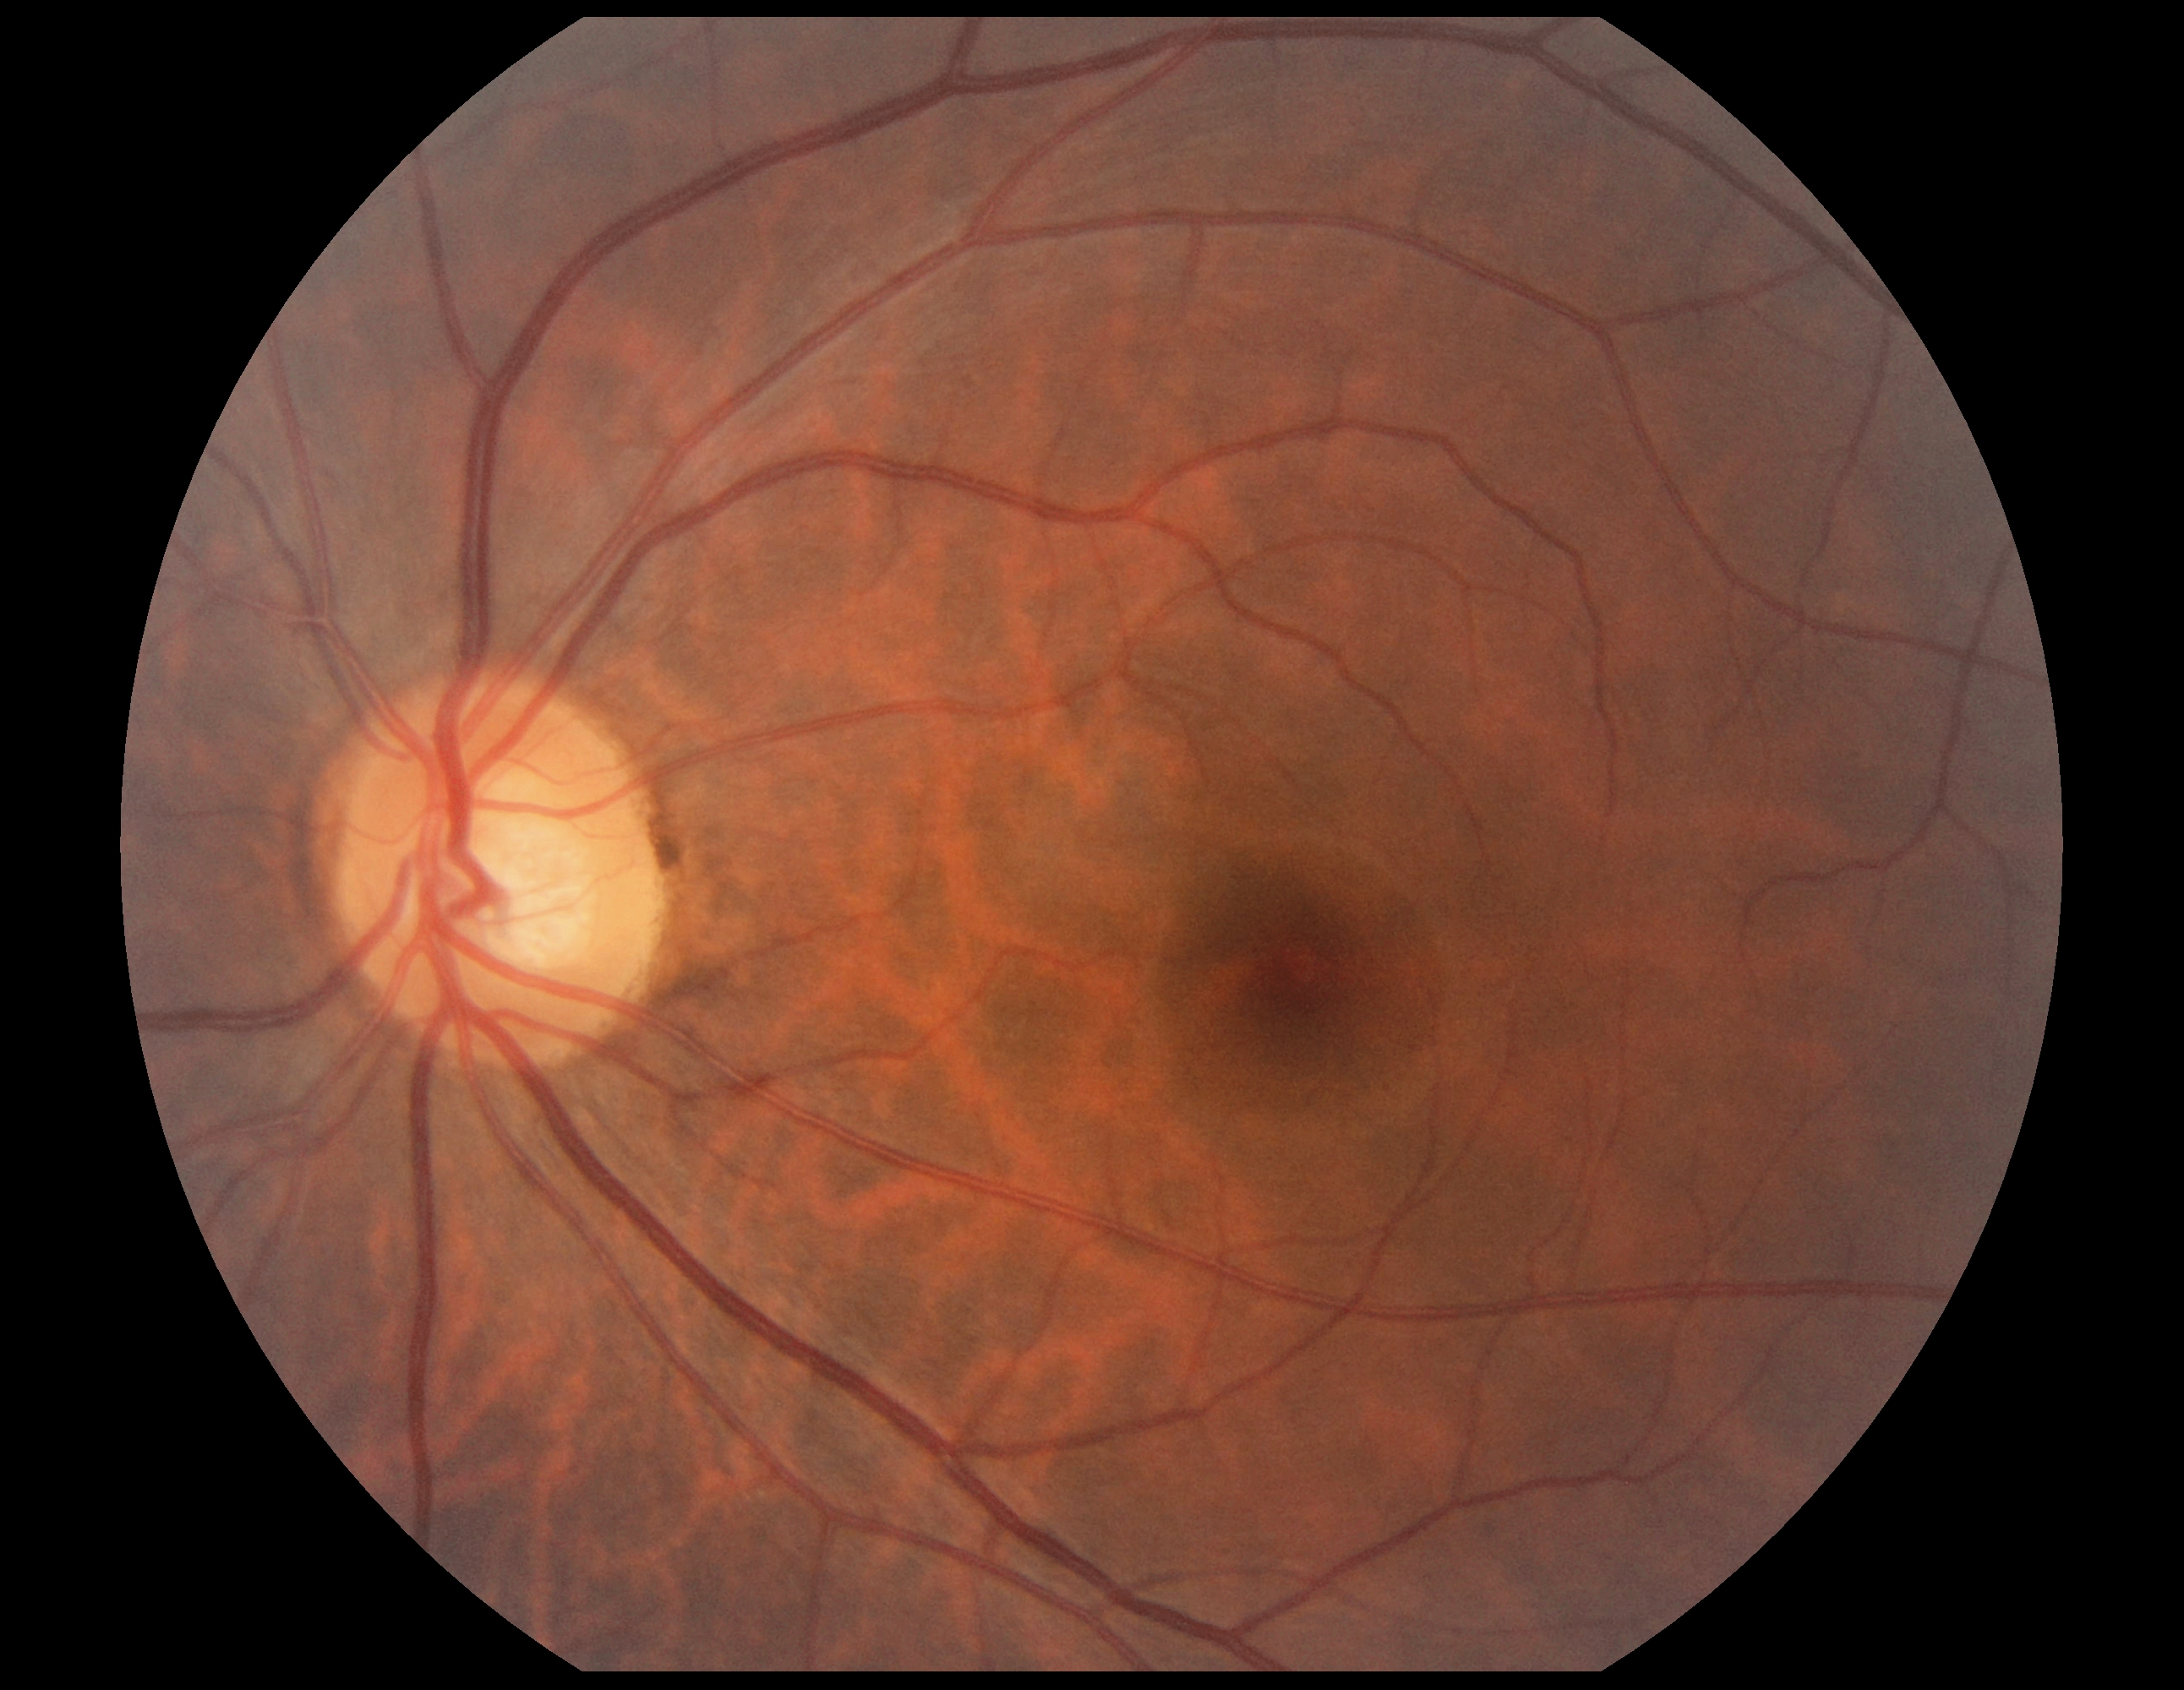

diabetic retinopathy: grade 0 (no apparent retinopathy) — no visible signs of diabetic retinopathy.